Color fundus image:
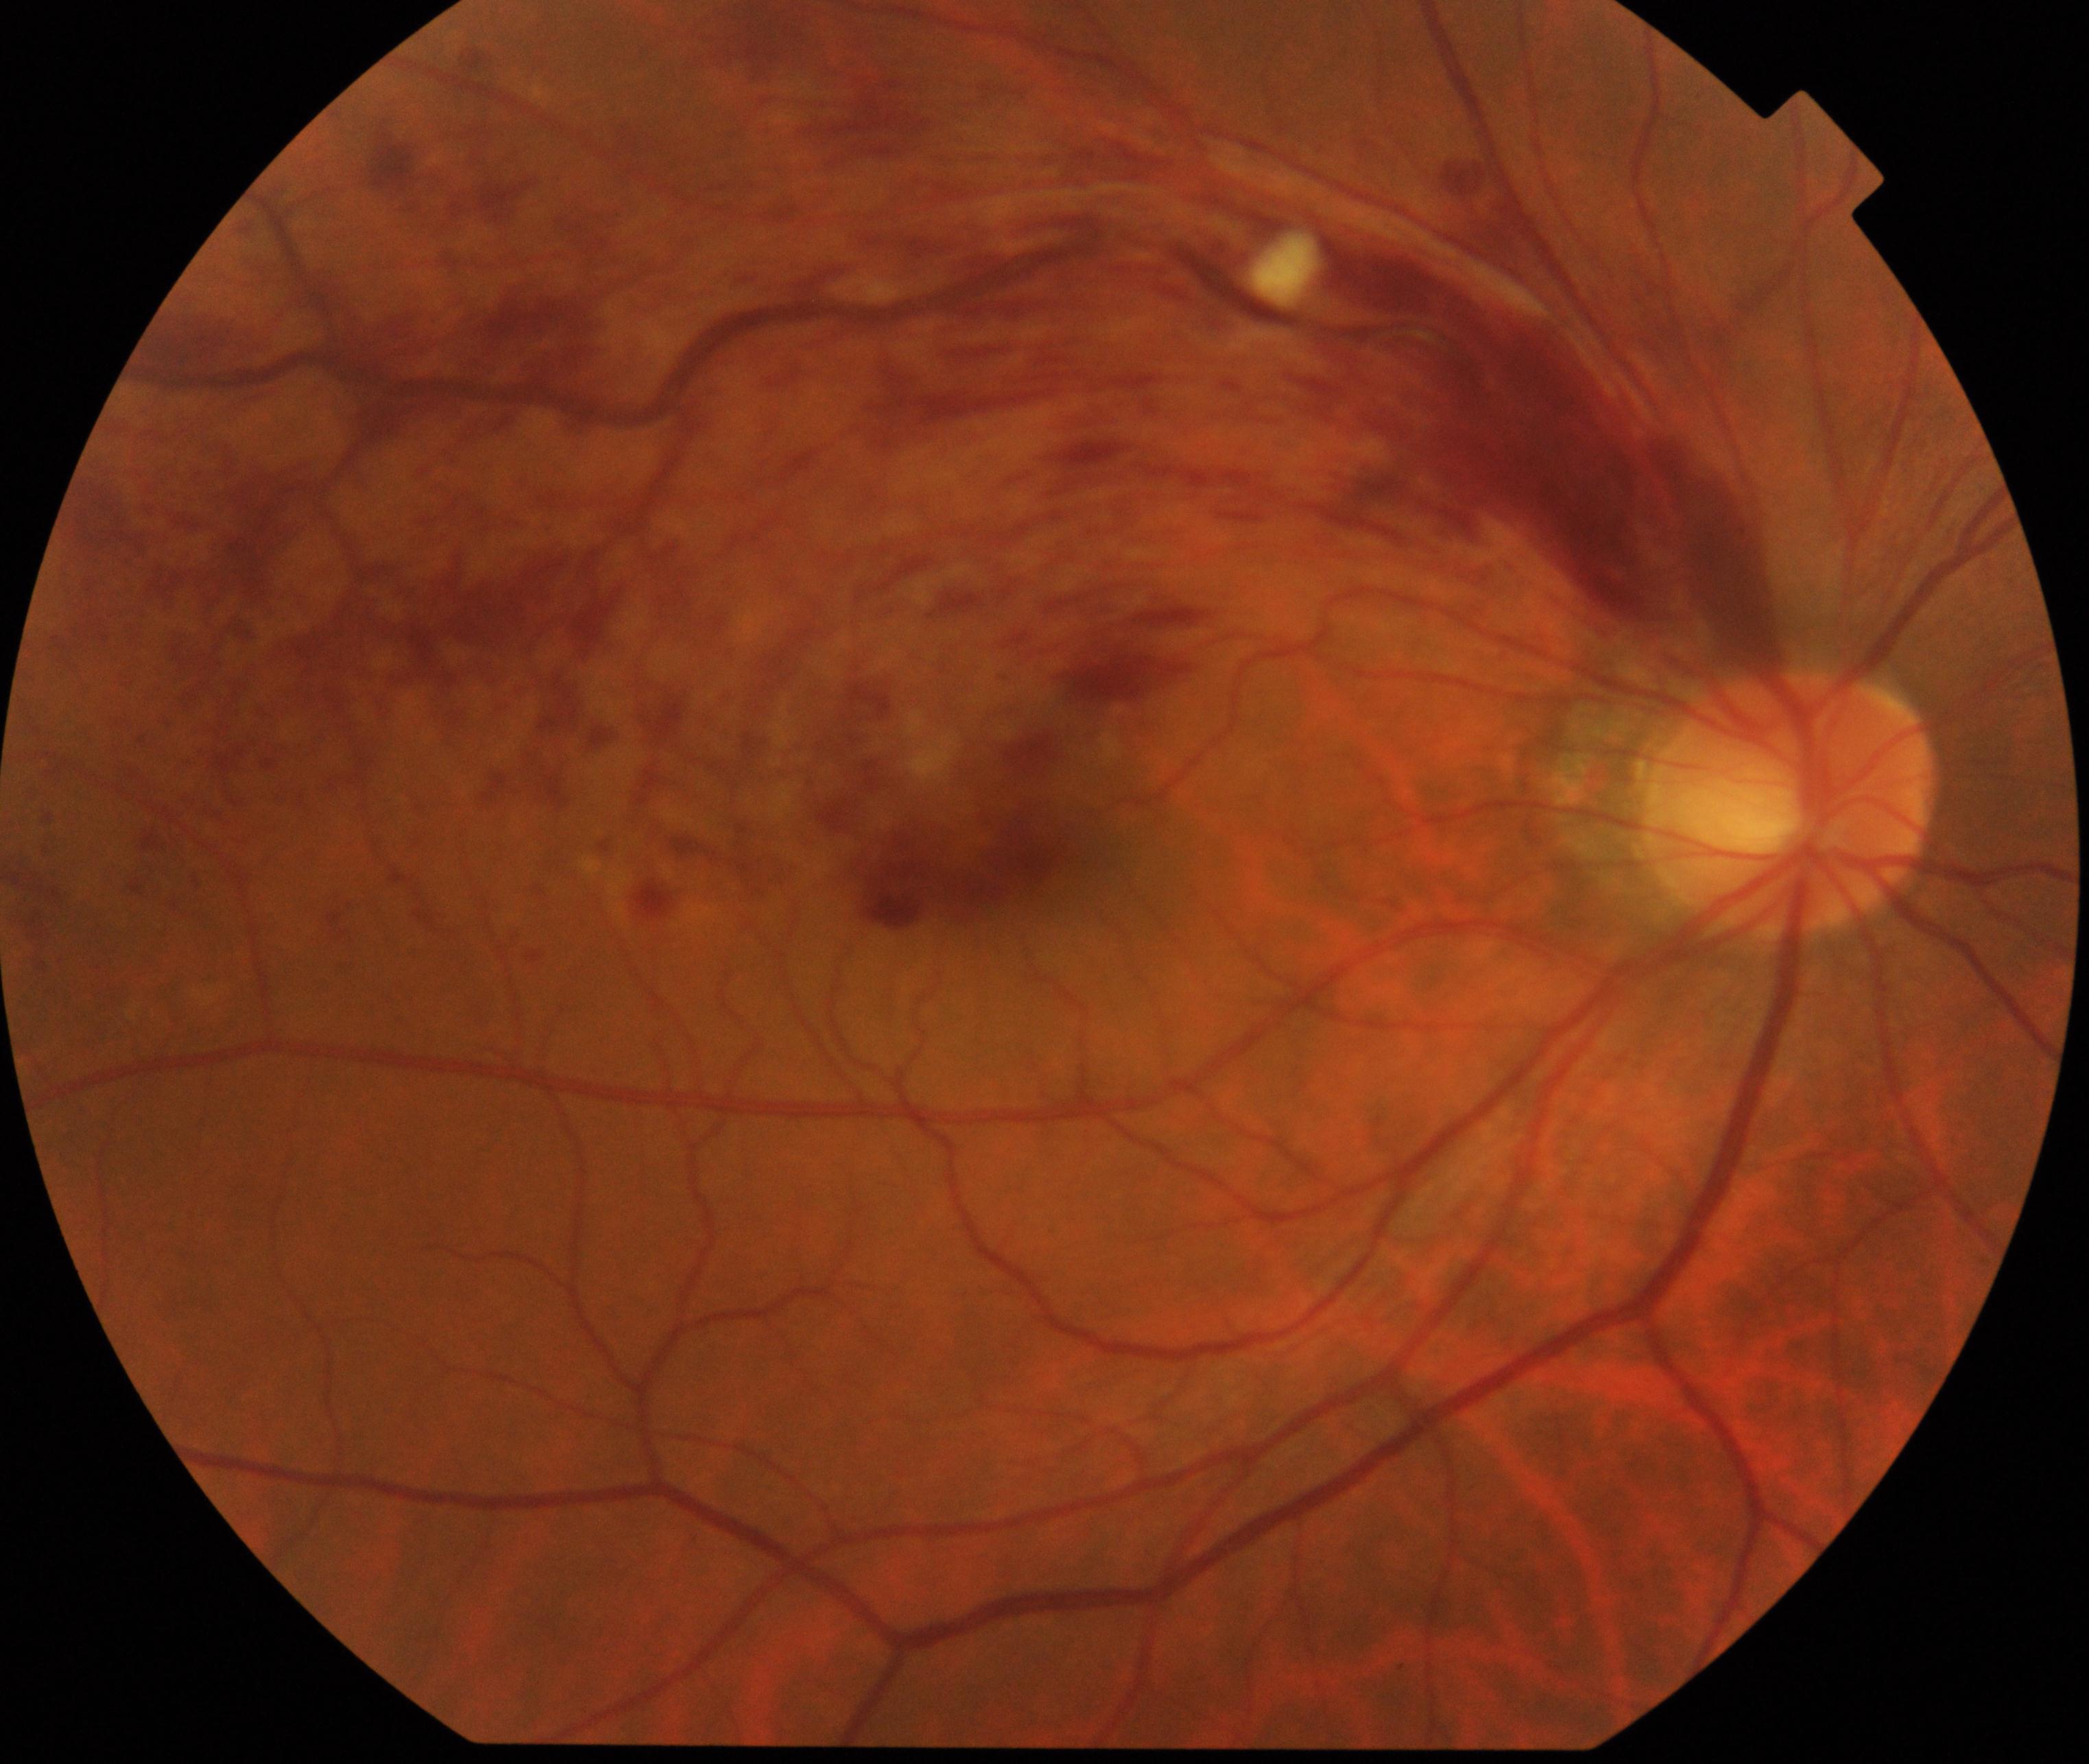
Impression: branch retinal vein occlusion. Features include tortuosity and dilatation of affected veins, with dot, blot, and flame hemorrhages, sometimes with cotton-wool spots or hard exudates.